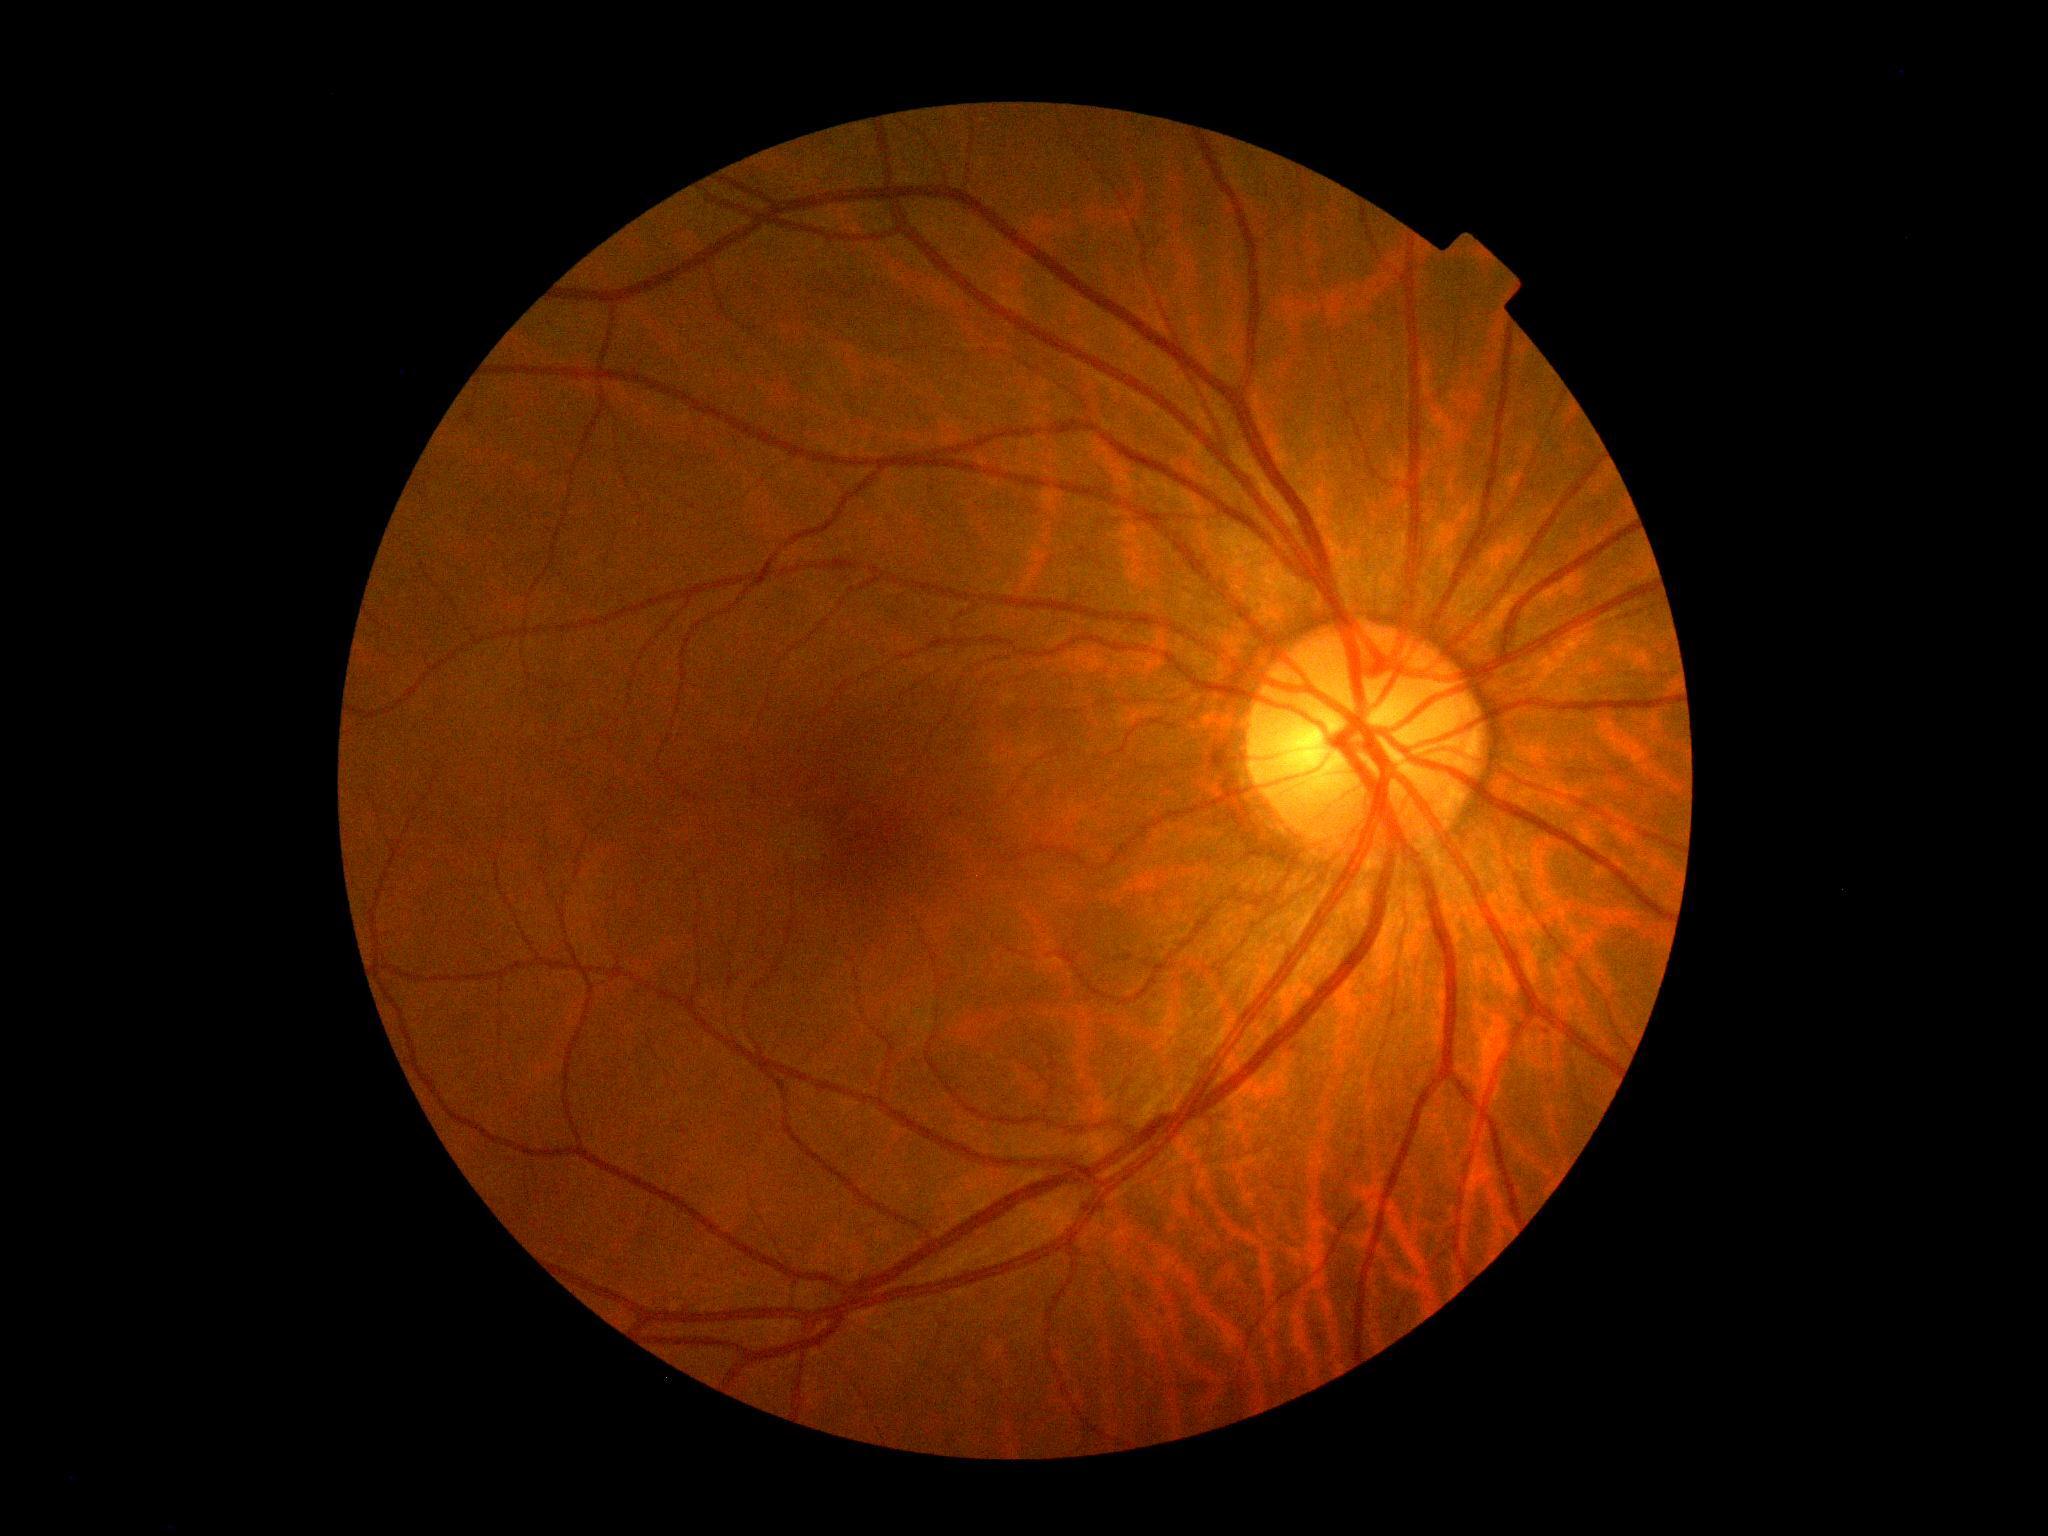

DR stage: grade 0 (no apparent retinopathy).